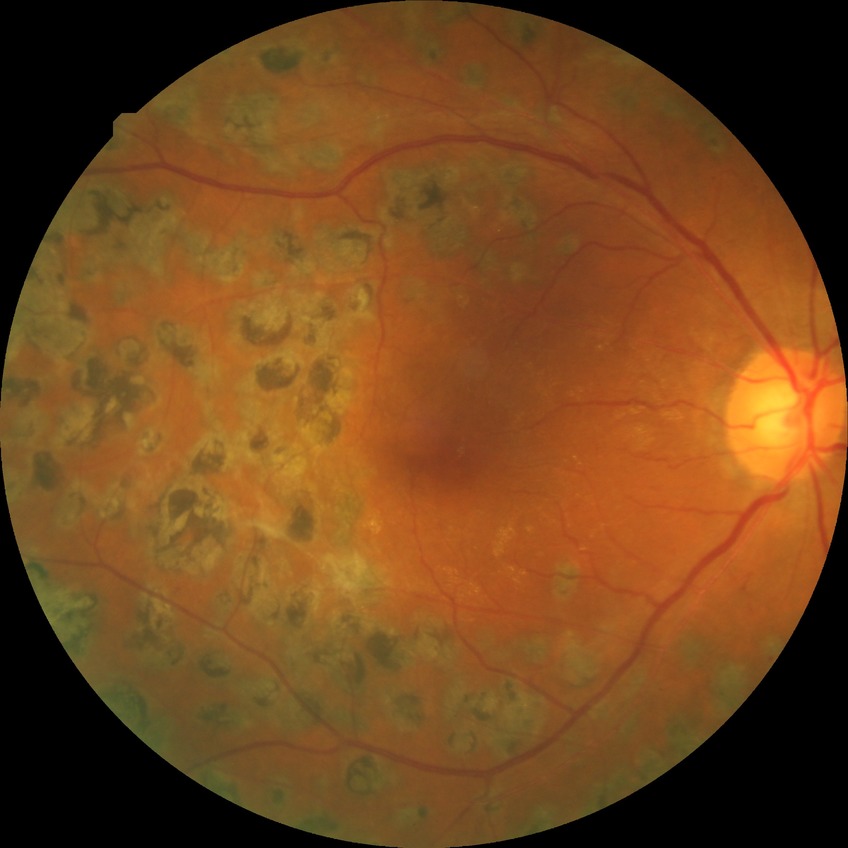
Diabetic retinopathy grade is proliferative diabetic retinopathy.